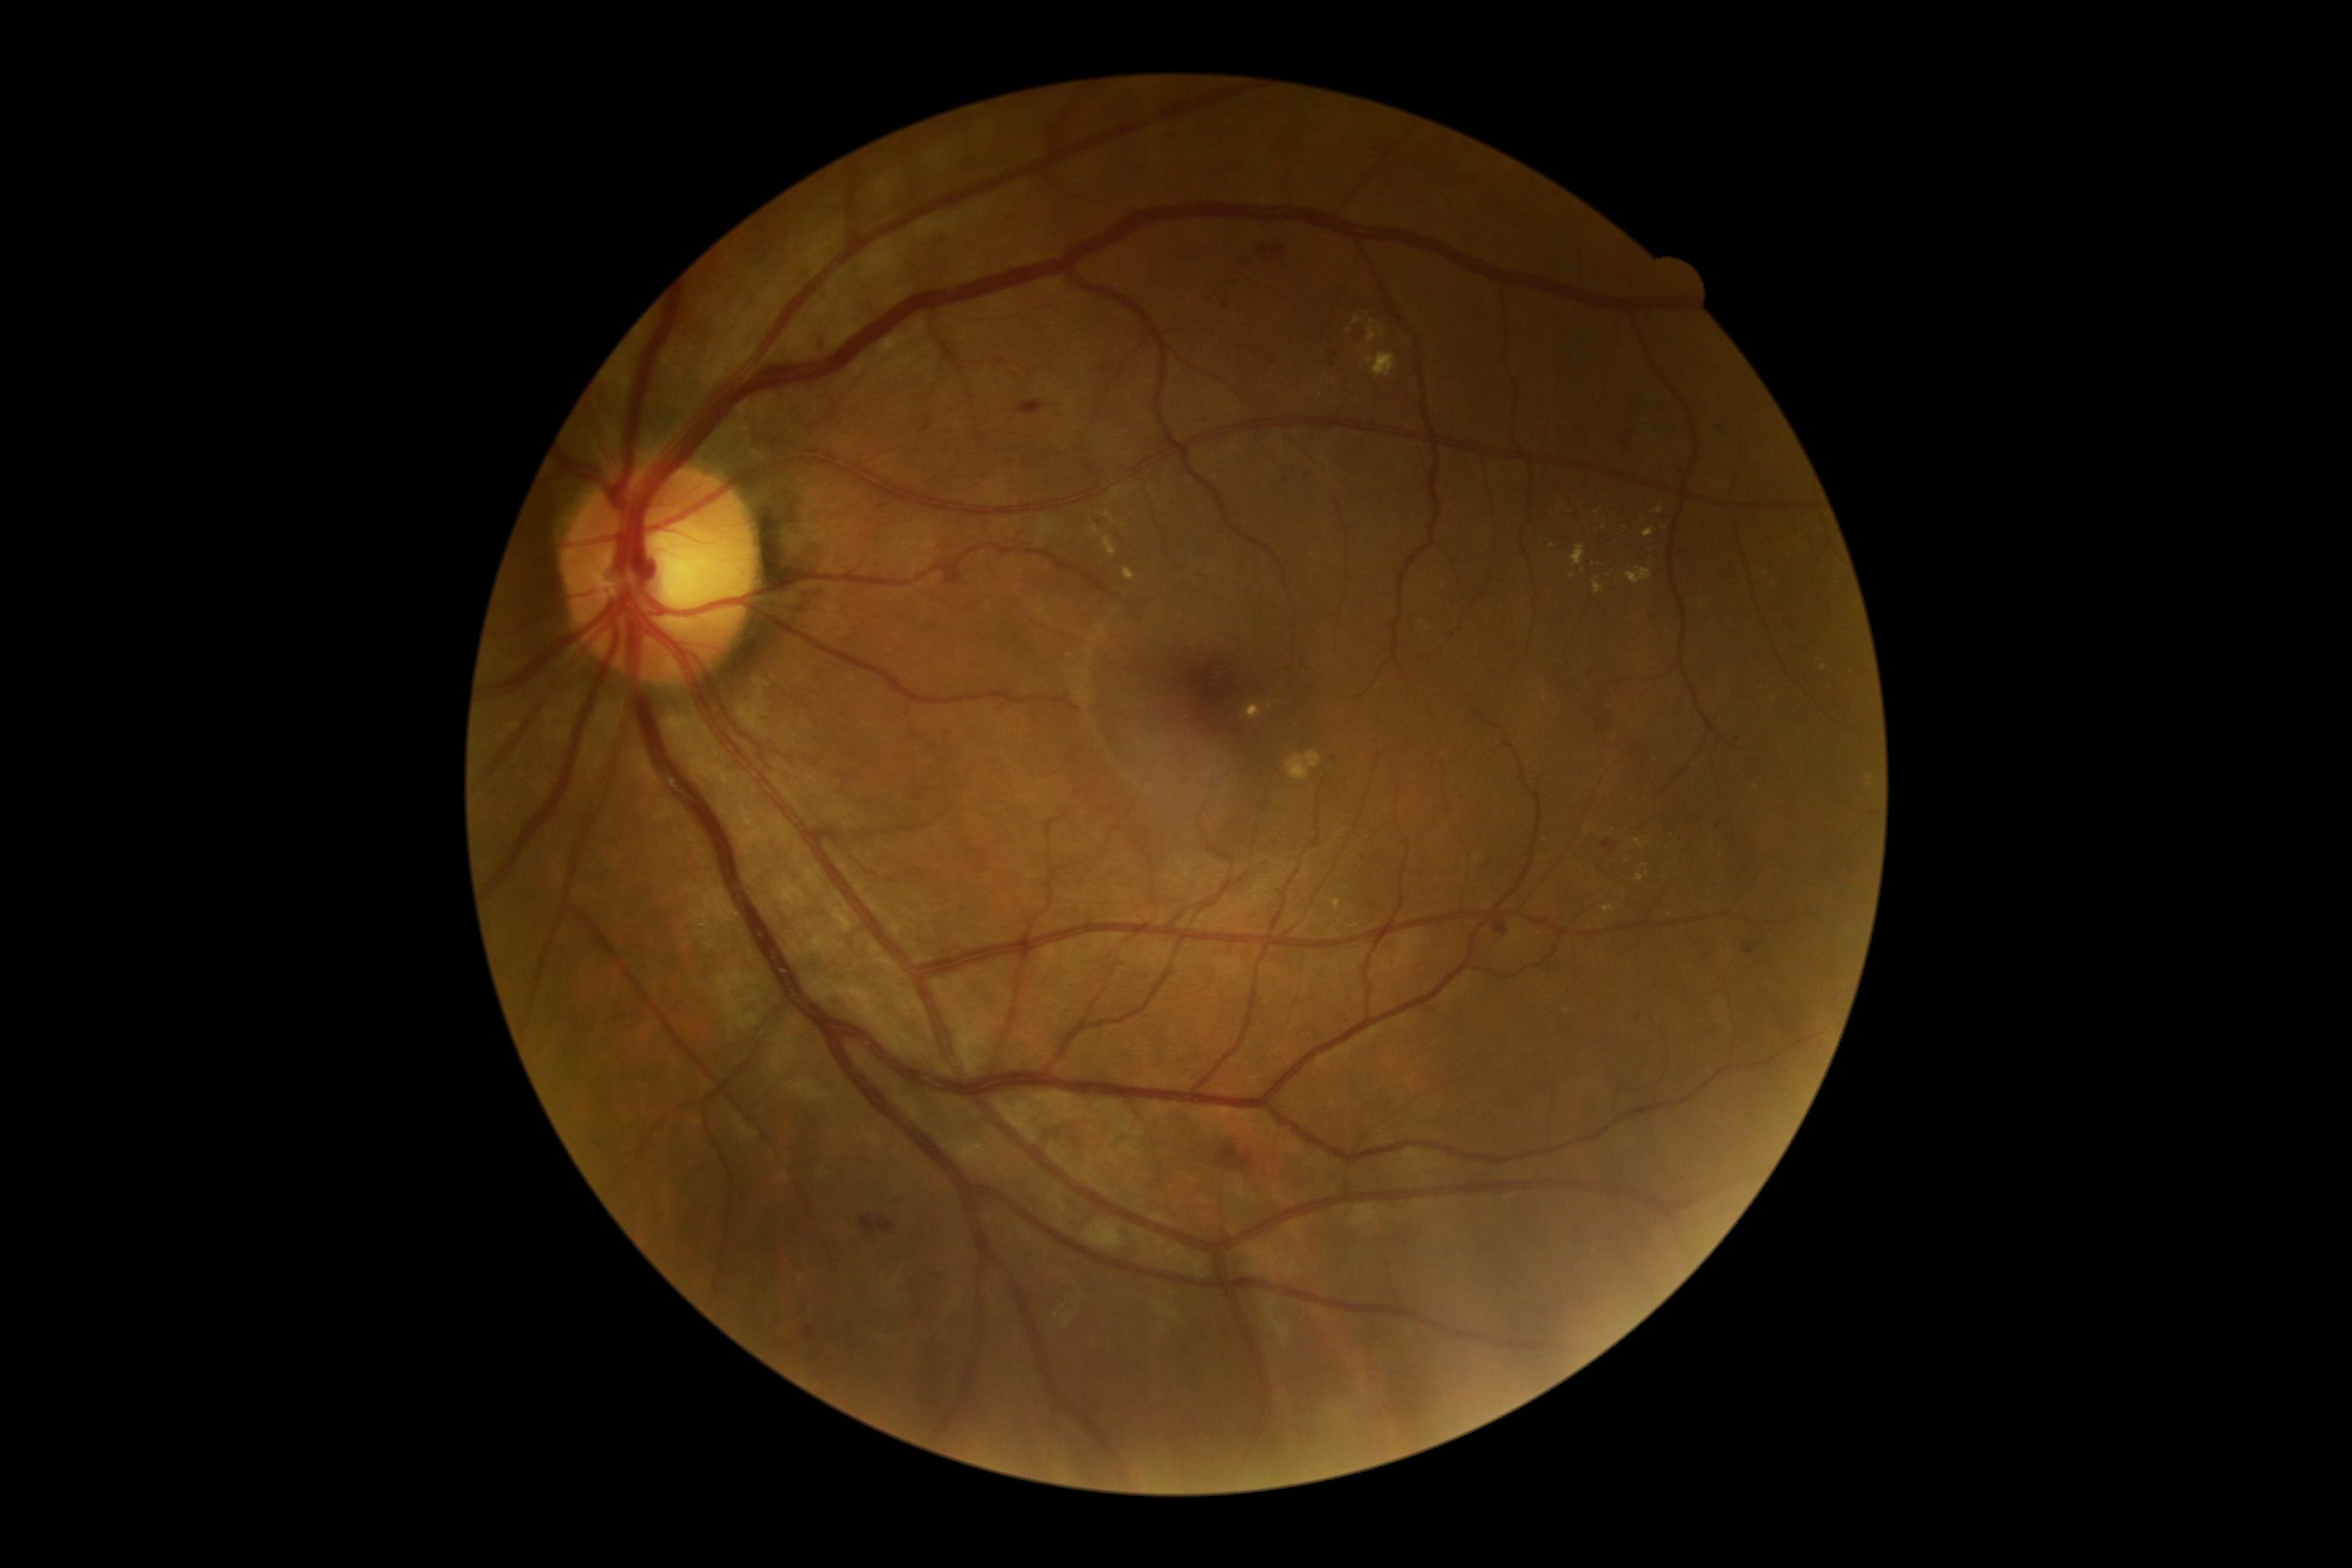 Diabetic retinopathy (DR) is grade 2 (moderate NPDR)
Lesions identified (partial list):
* hard exudates (EXs) (continued): box(1103, 510, 1115, 524), box(1653, 506, 1663, 515), box(1636, 874, 1645, 883), box(1332, 900, 1340, 910), box(1124, 570, 1136, 580), box(1103, 537, 1117, 556), box(1626, 568, 1651, 584), box(1638, 515, 1646, 522), box(1595, 582, 1603, 594)
* Small EXs approximately at {"x": 1583, "y": 572}, {"x": 1361, "y": 350}, {"x": 1349, "y": 331}, {"x": 1573, "y": 577}, {"x": 1664, "y": 527}